Wide-field contact fundus photograph of an infant · 640 by 480 pixels · 130° field of view (Clarity RetCam 3)
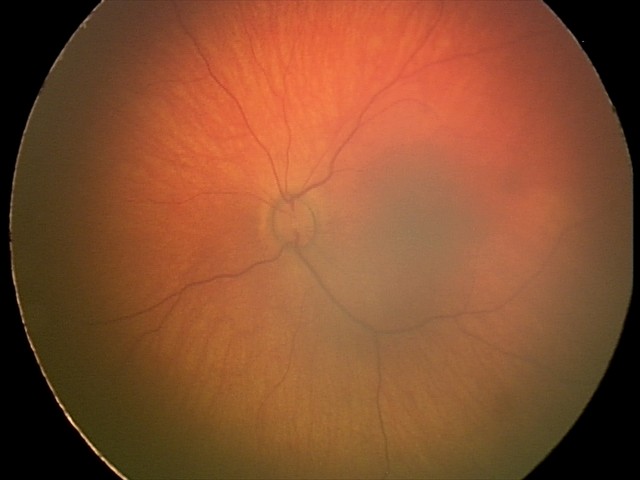

Diagnosis from this screening exam: retinal hemorrhages.